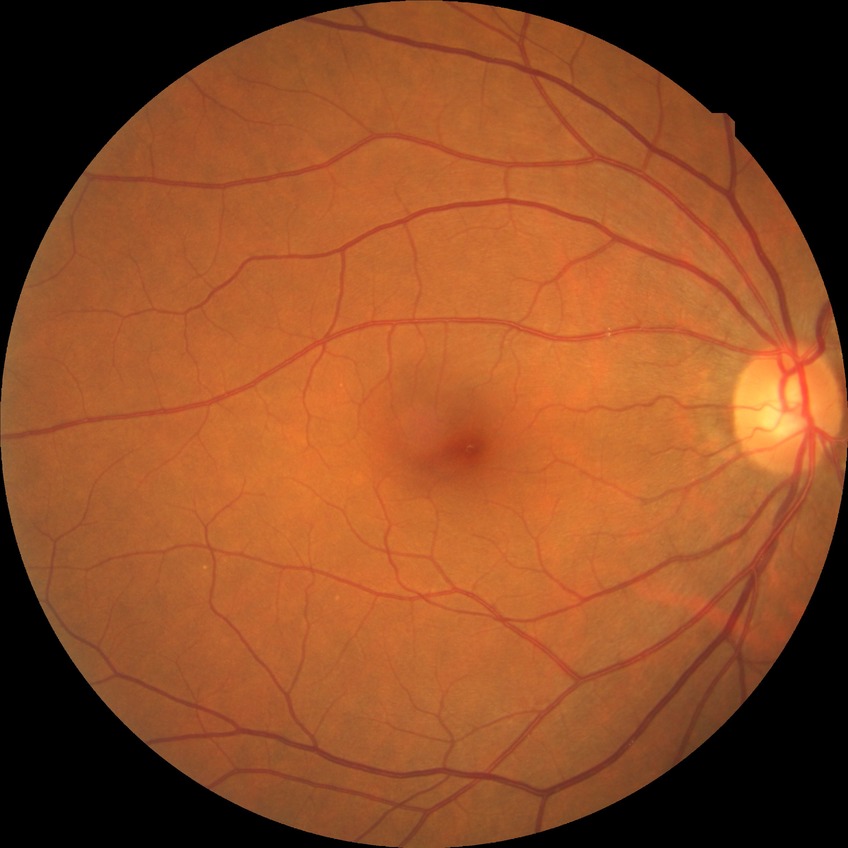 Assessment:
* diabetic retinopathy (DR): NDR (no diabetic retinopathy)